1240x1240px · camera: Phoenix ICON (100° FOV) · wide-field contact fundus photograph of an infant
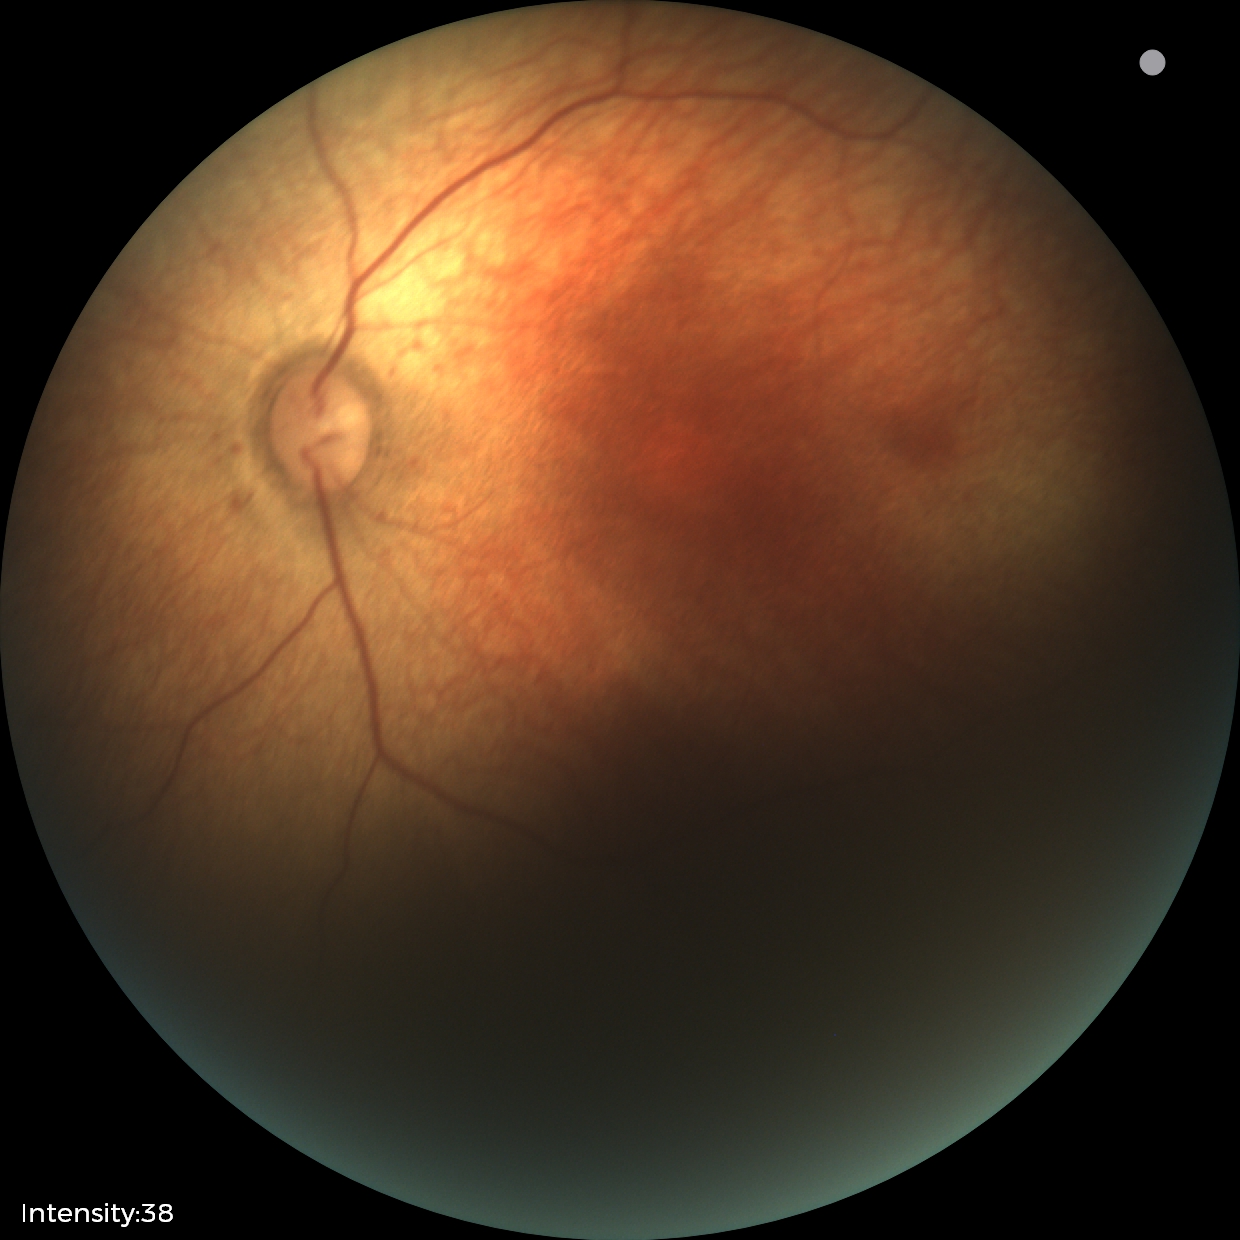
Examination with physiological retinal findings.